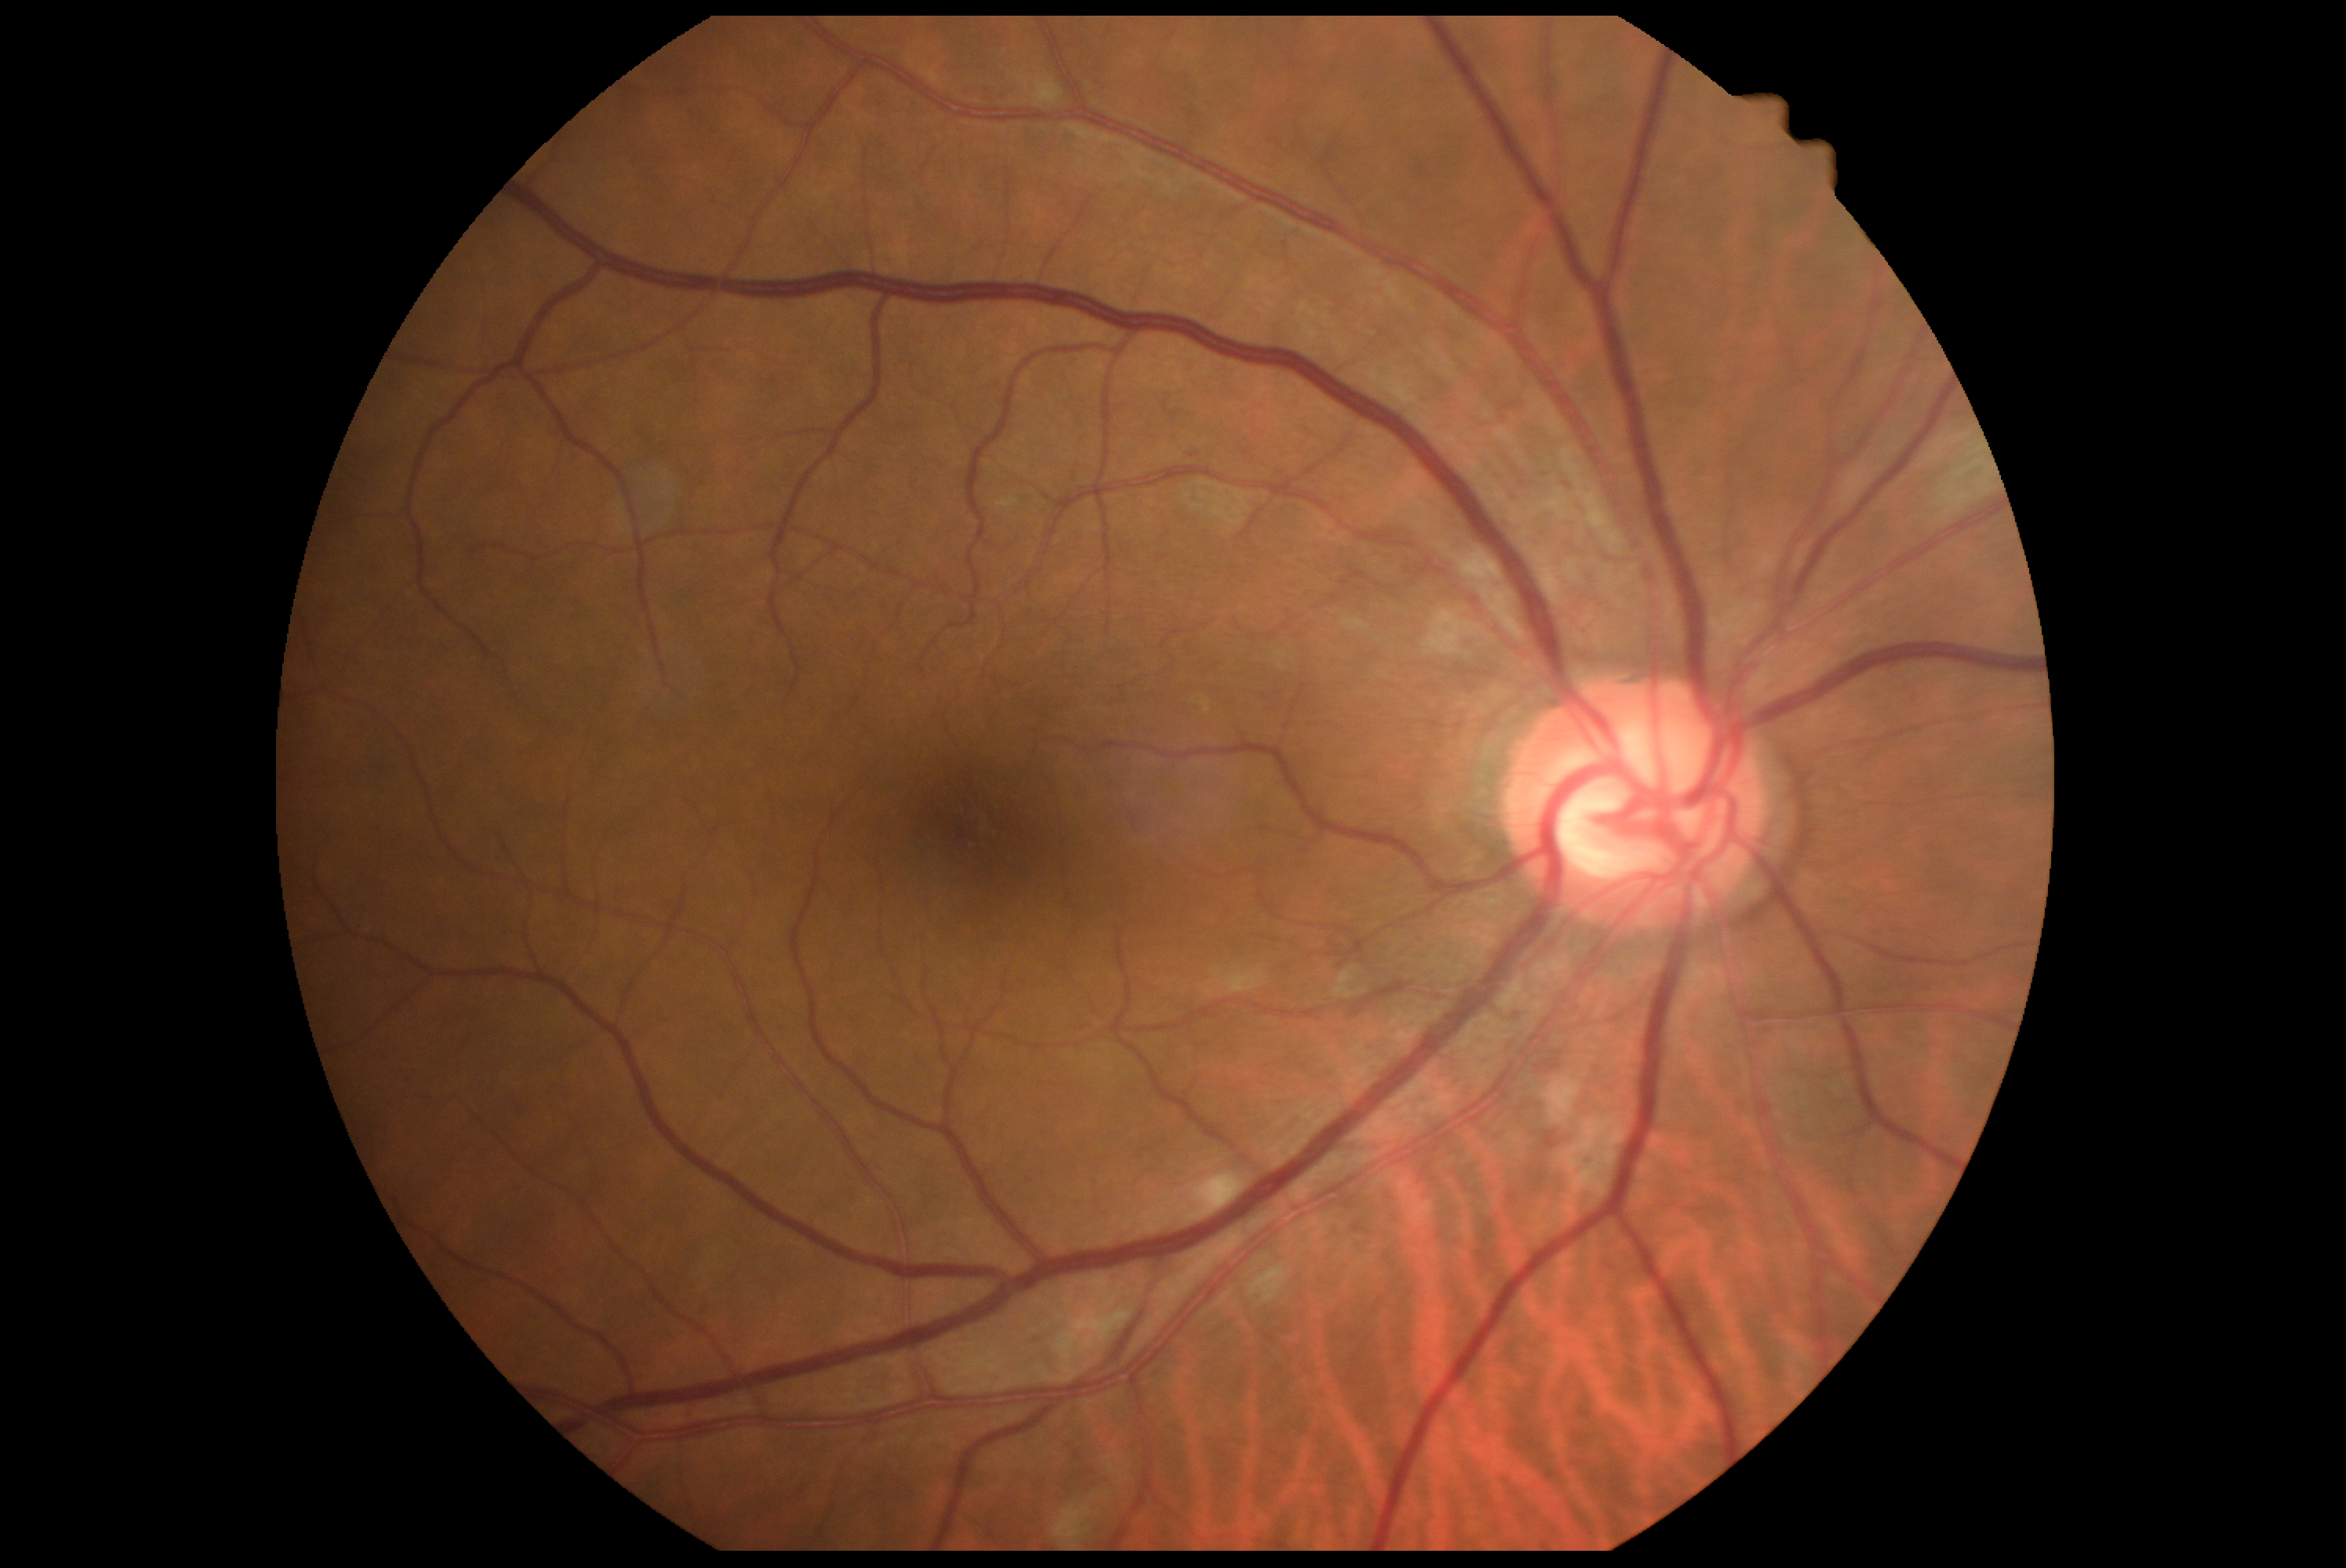
Diabetic retinopathy (DR): 2/4 — more than just microaneurysms but less than severe NPDR. The retinopathy is classified as non-proliferative diabetic retinopathy.